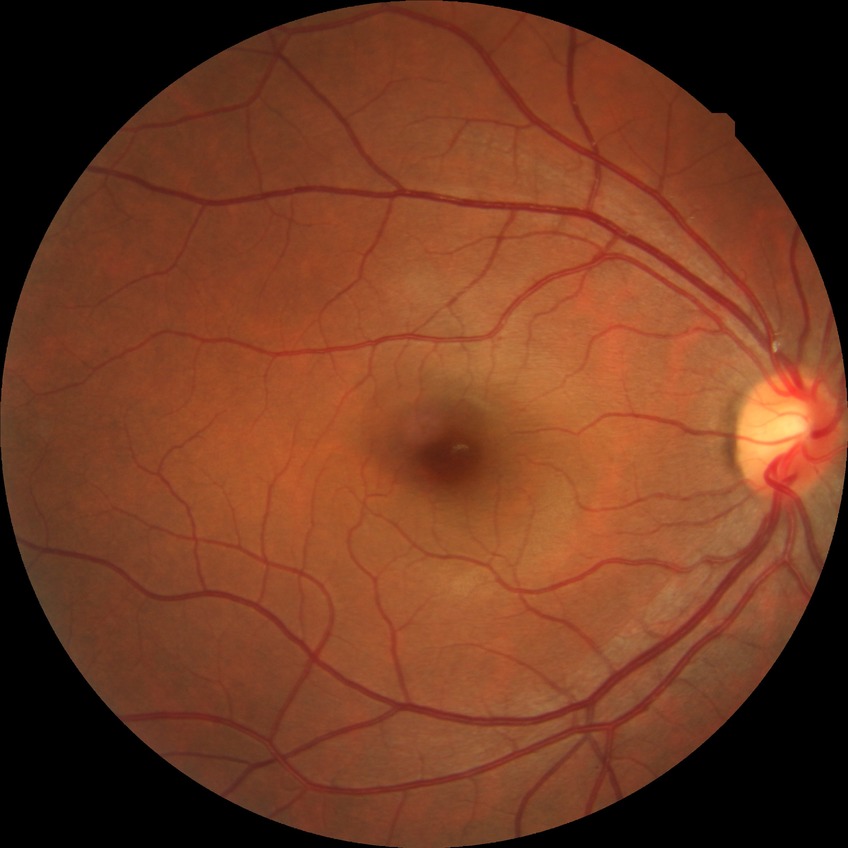

Modified Davis classification is no diabetic retinopathy.